1936 x 1296 pixels · 45° field of view.
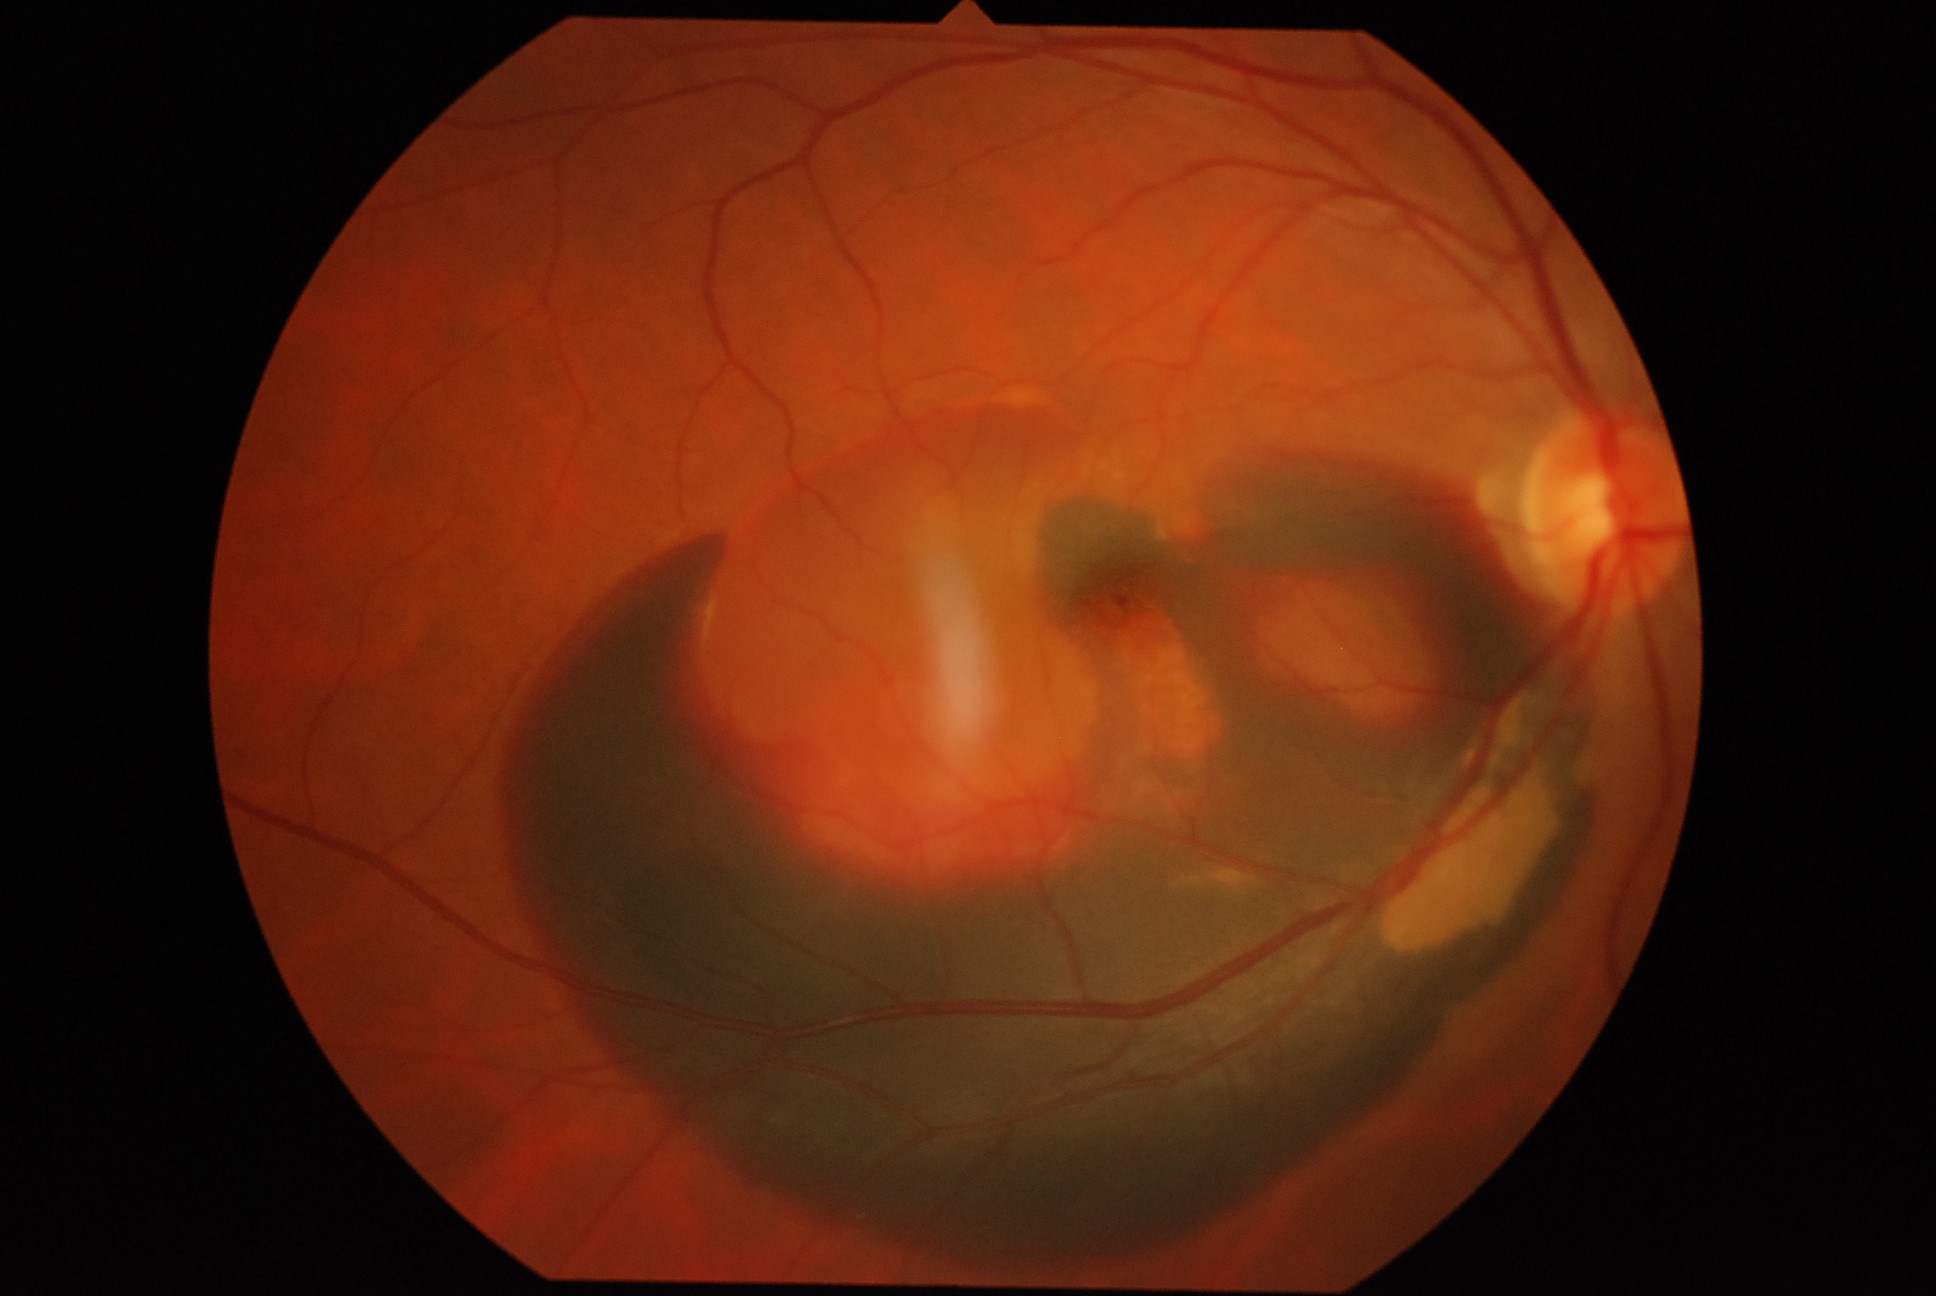 {
  "dr_grade": "proliferative diabetic retinopathy (grade 4)"
}